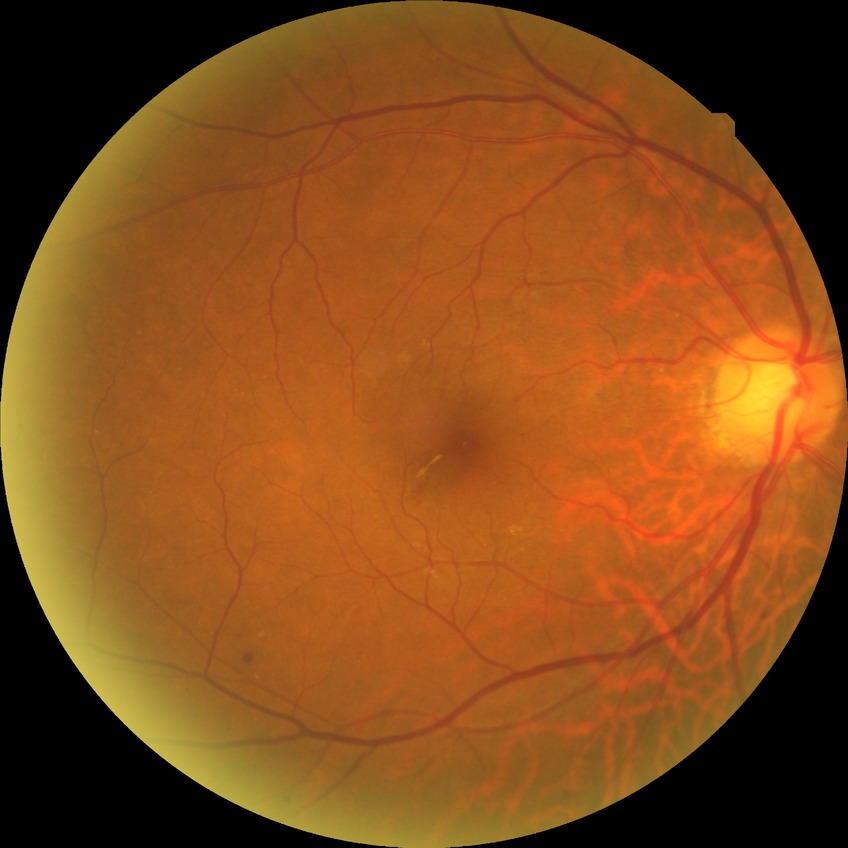

Retinopathy stage: simple diabetic retinopathy.